Image size 848x848
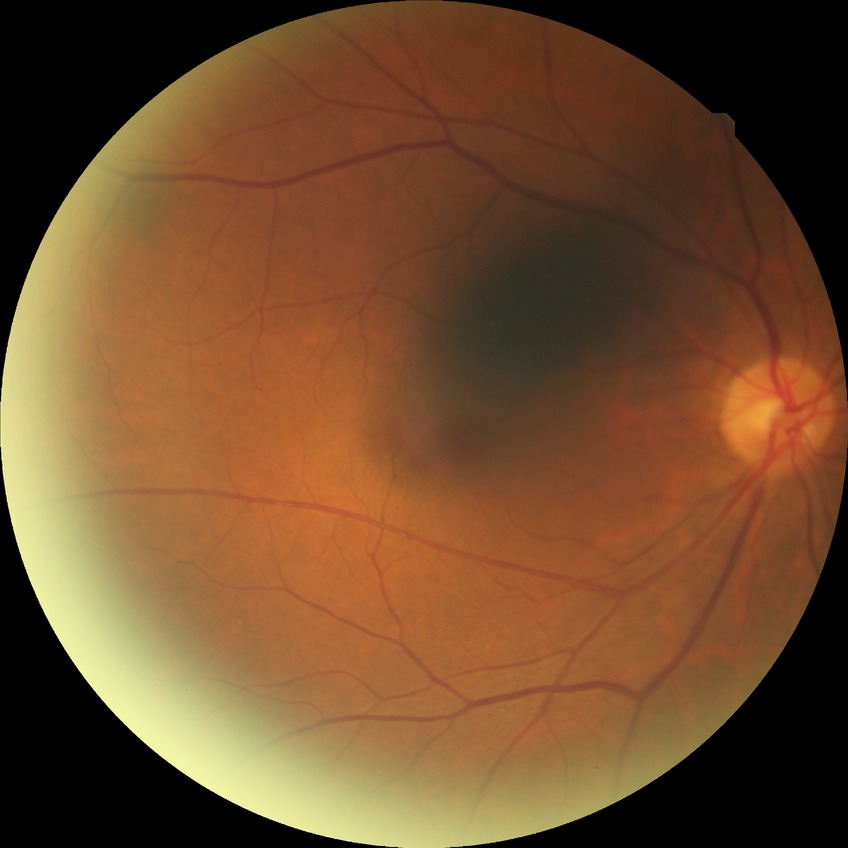

Diabetic retinopathy severity: no diabetic retinopathy.